FOV: 45 degrees; fundus photo
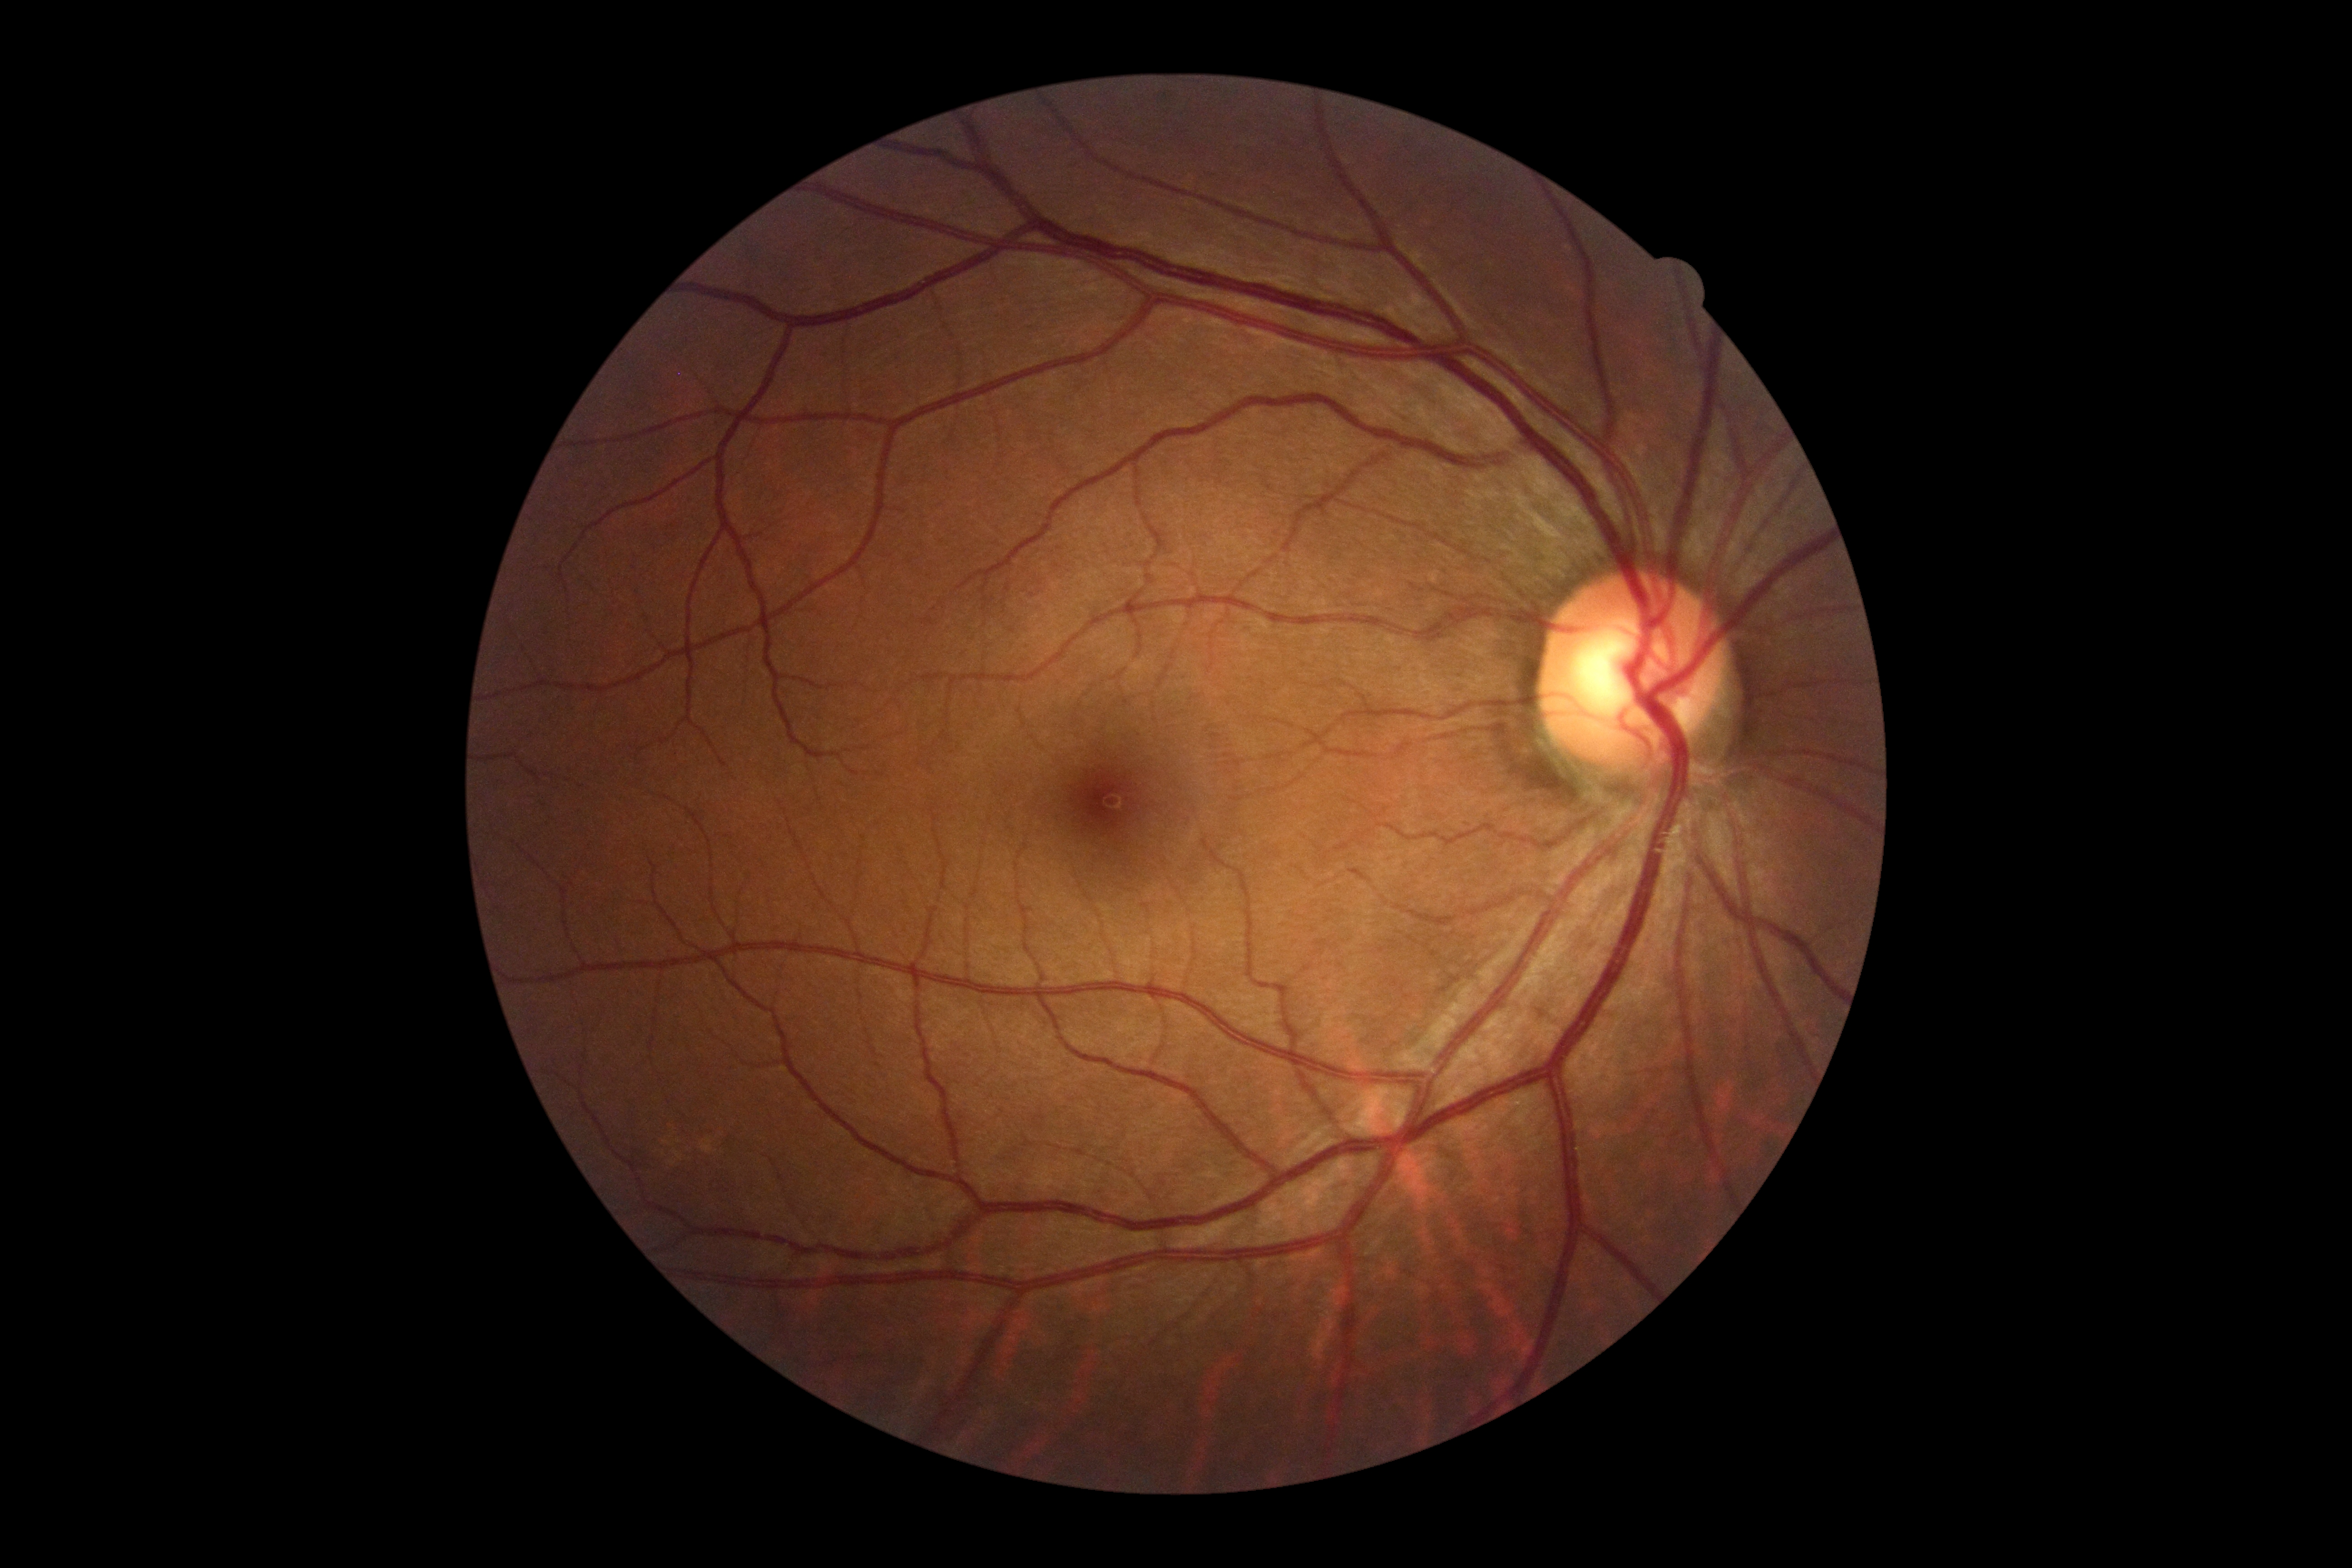

Diabetic retinopathy (DR) is no apparent diabetic retinopathy (grade 0) — no visible signs of diabetic retinopathy.